Acquired on the Phoenix ICON · wide-field fundus image from infant ROP screening · 1240x1240px — 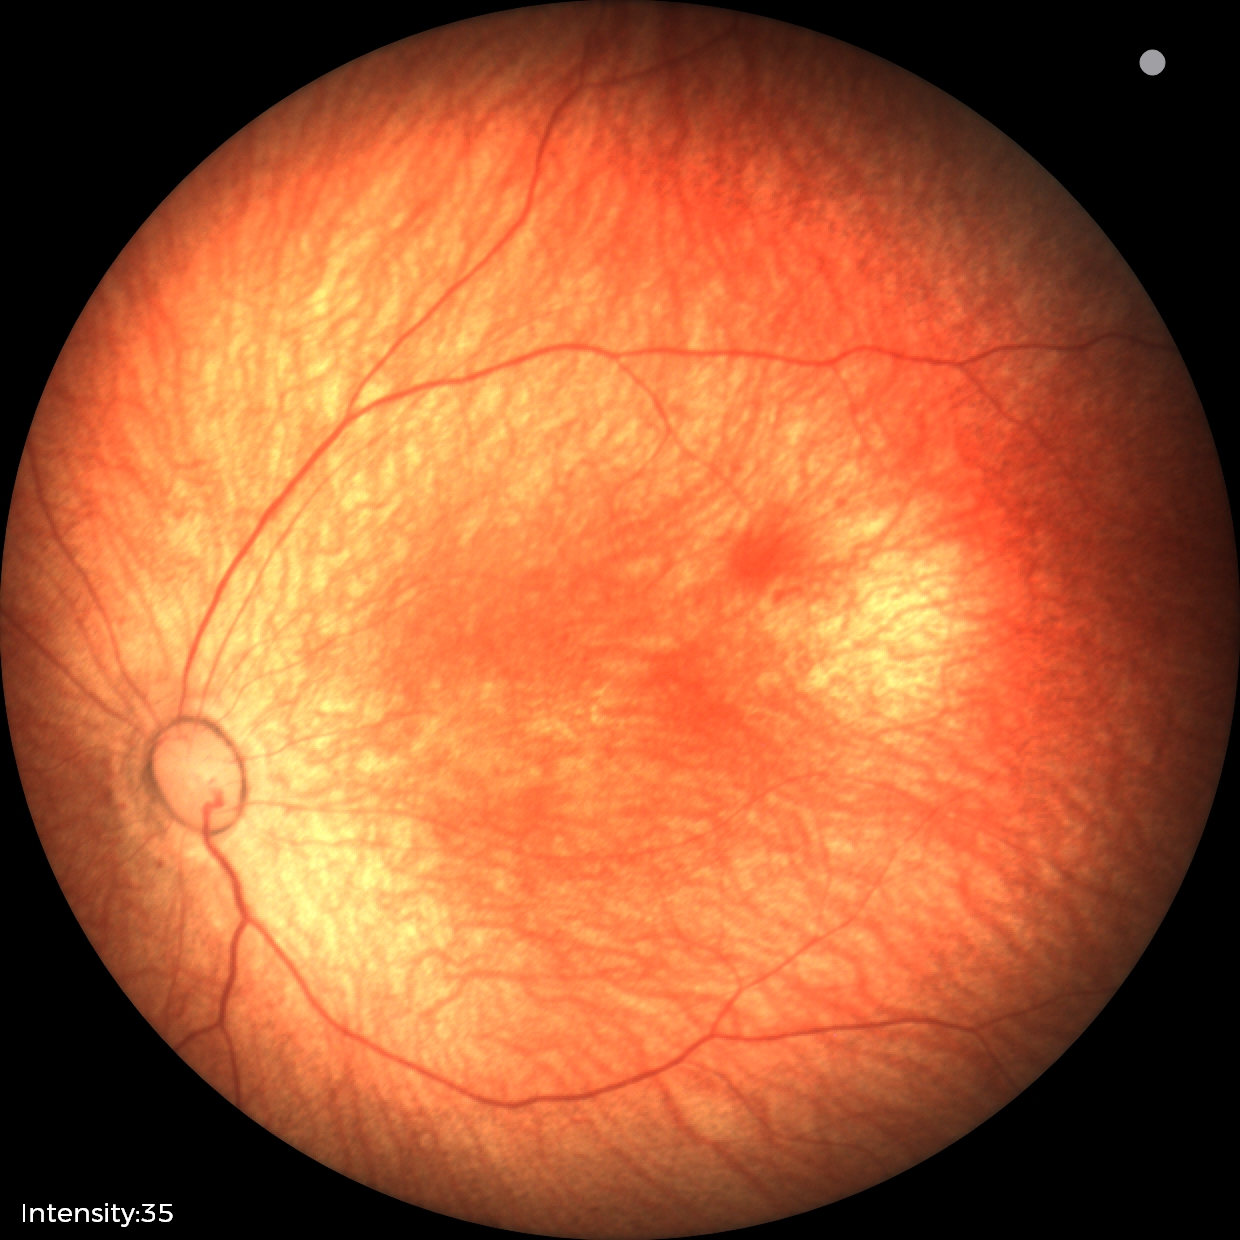 Q: What is the diagnosis from this examination?
A: normal retinal appearance